Image size 2352x1568, fundus photo, FOV: 45 degrees: 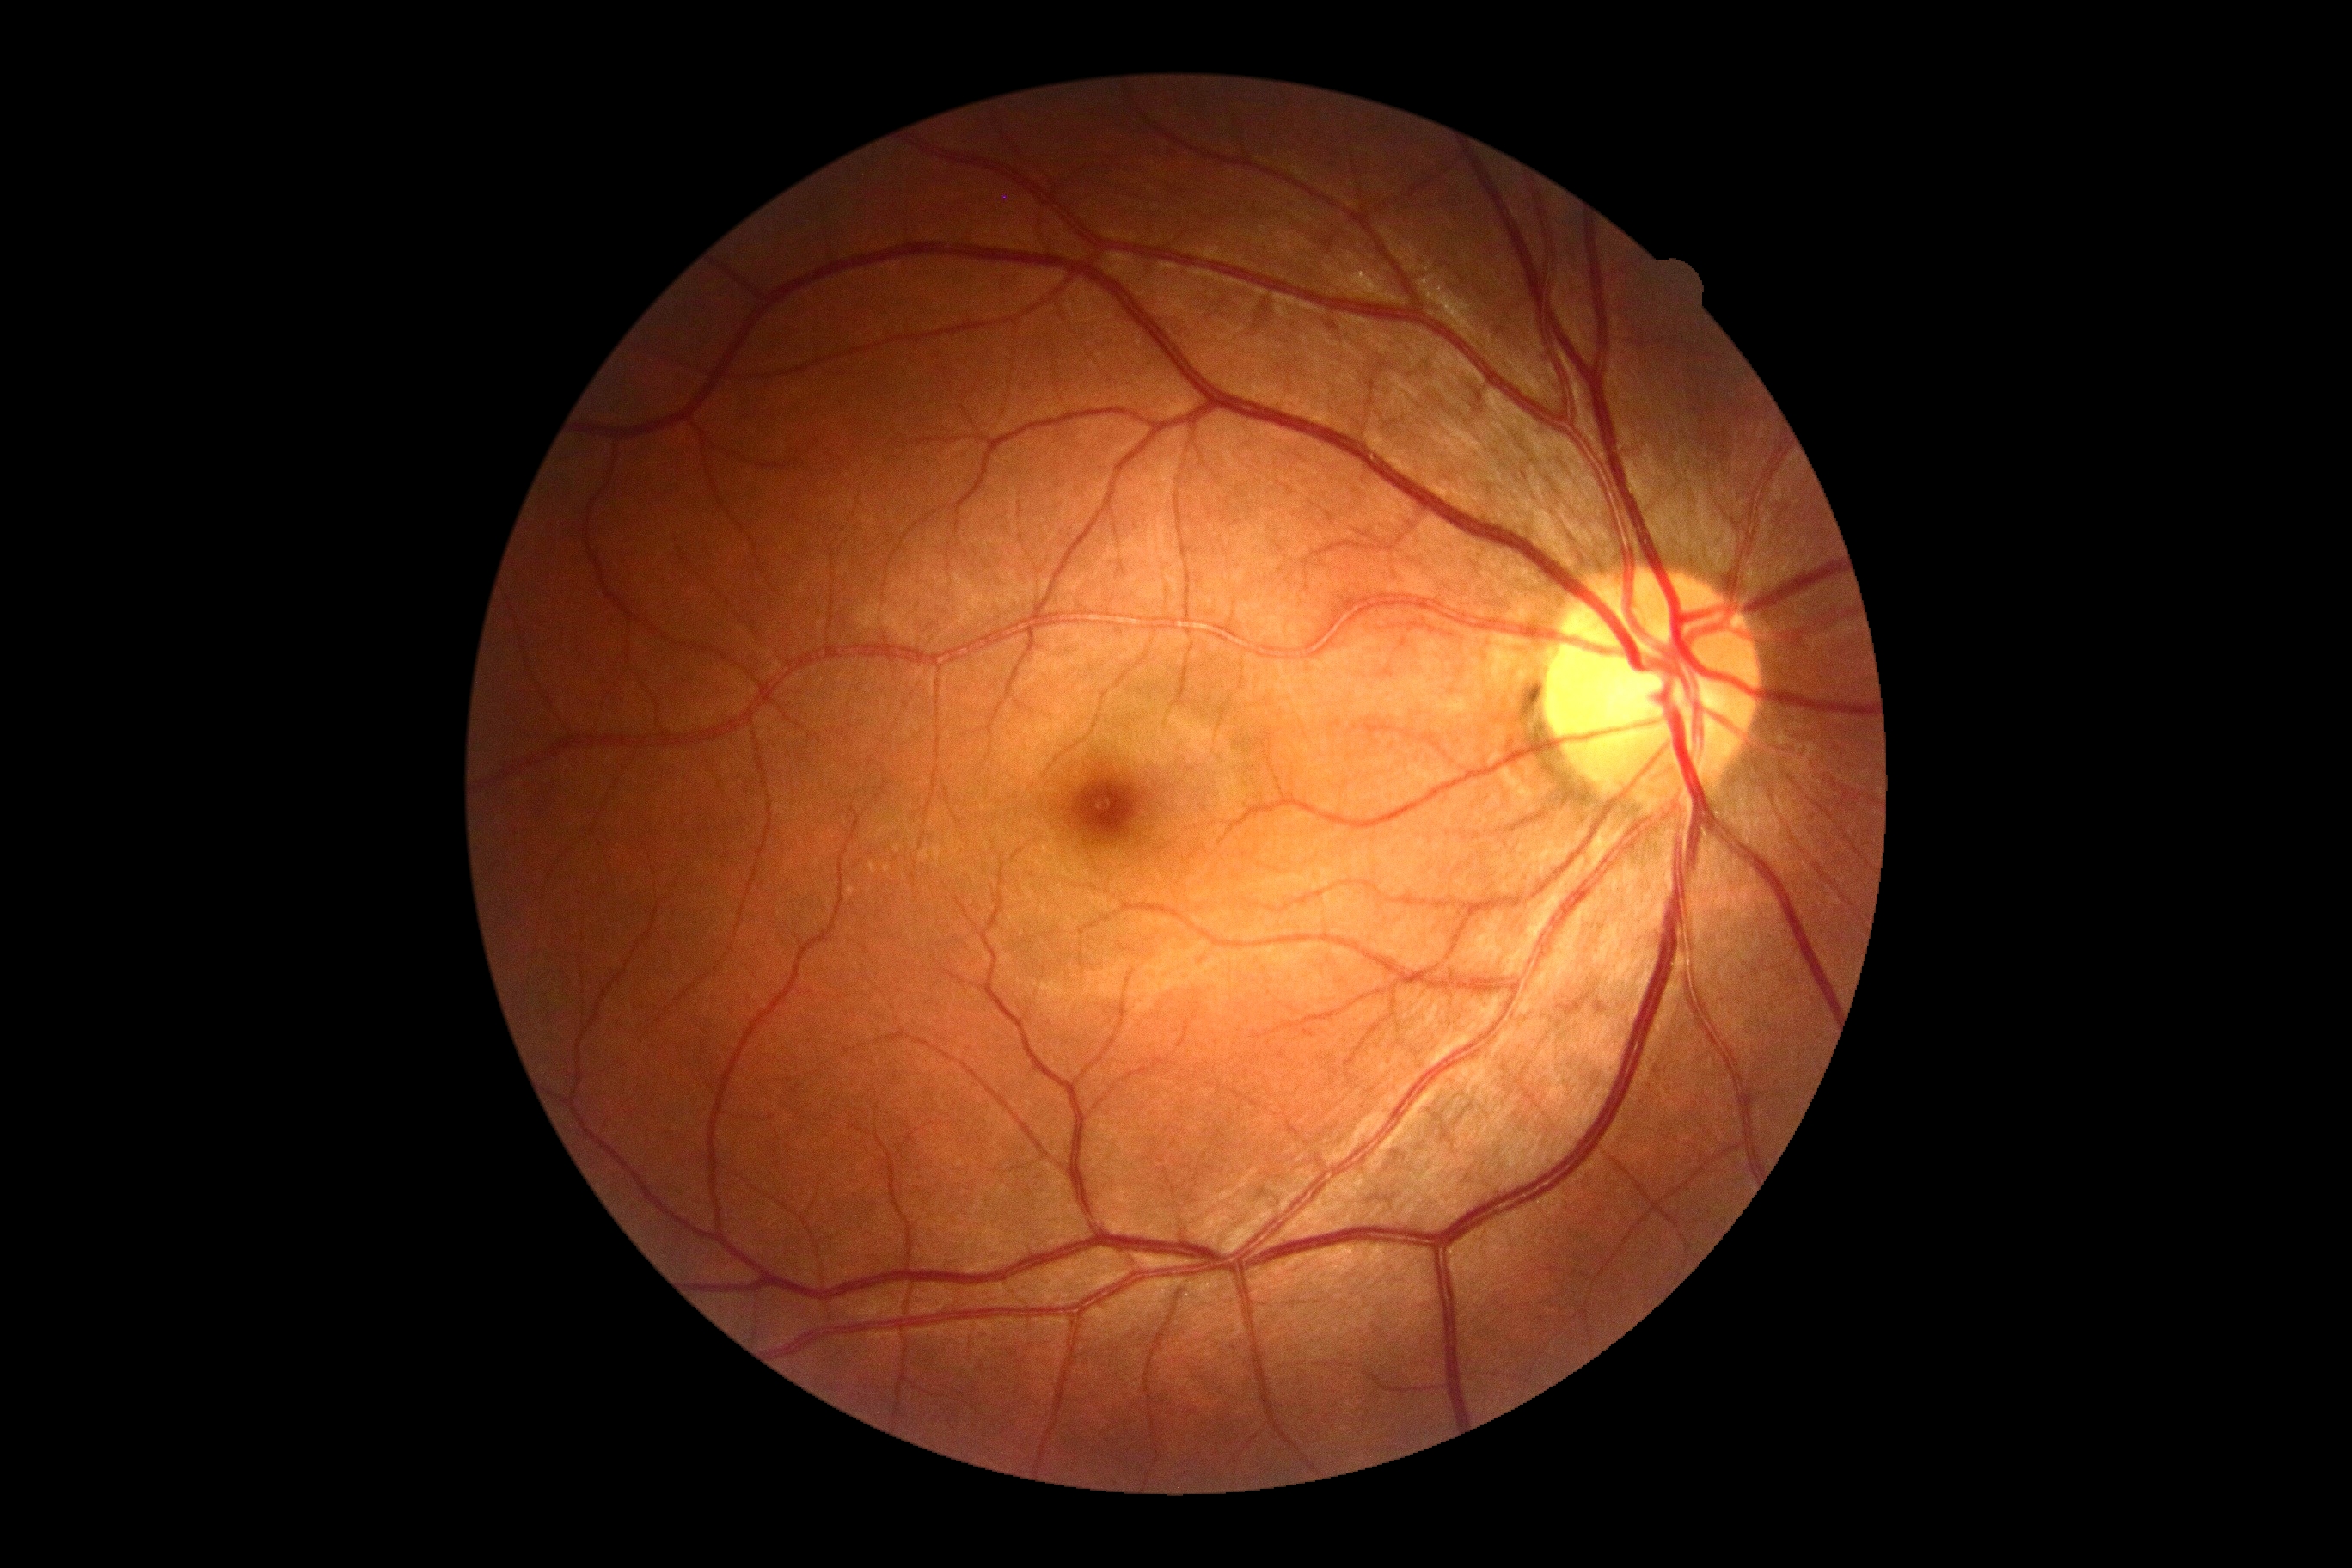
DR grade: 0 (no apparent retinopathy).